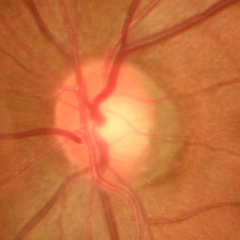 Q: Does this eye have glaucoma?
A: Early glaucomatous changes.